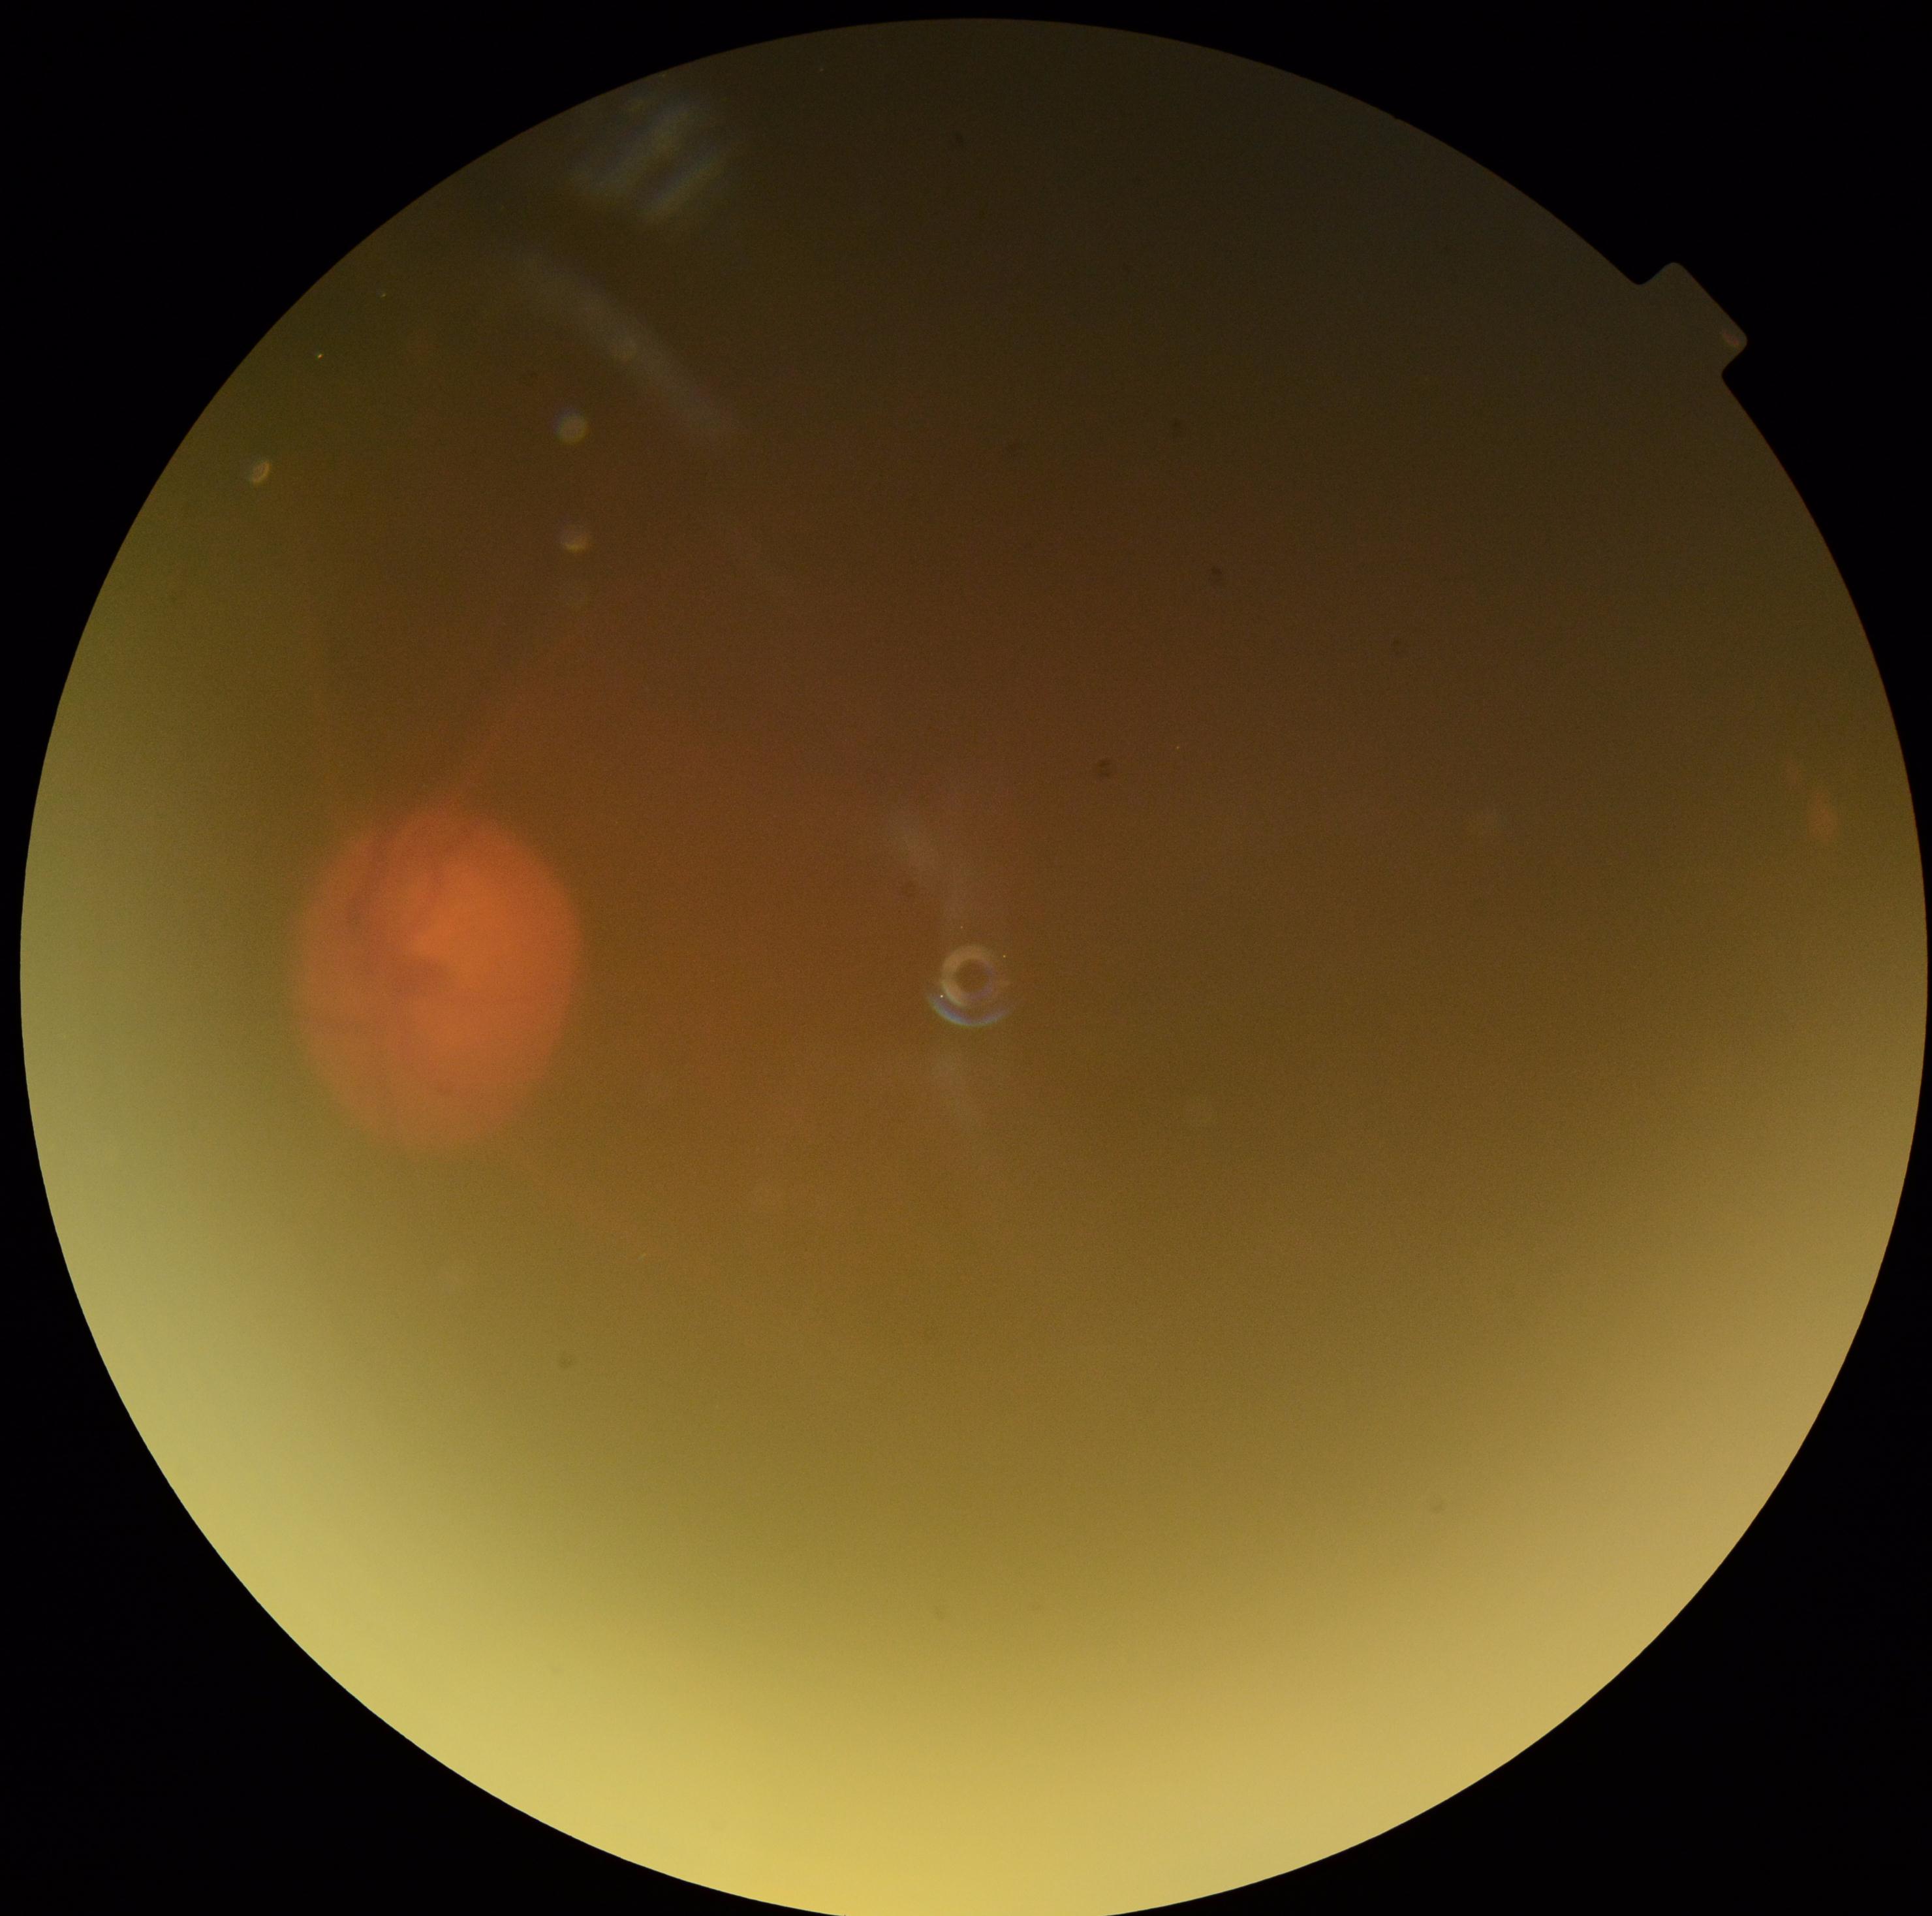 DR stage: ungradable due to poor image quality.
Image quality is insufficient for diabetic retinopathy assessment.